Optic disc photograph — 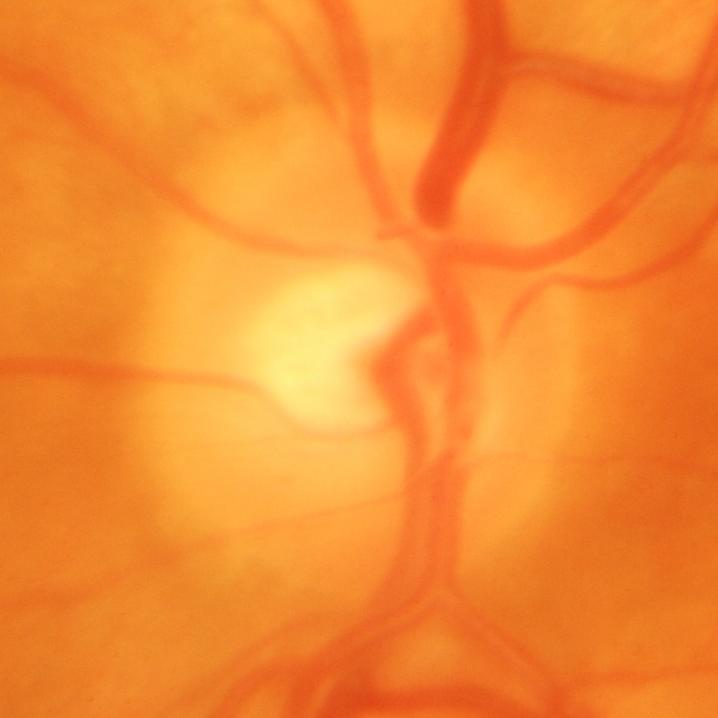

Showing glaucomatous findings.